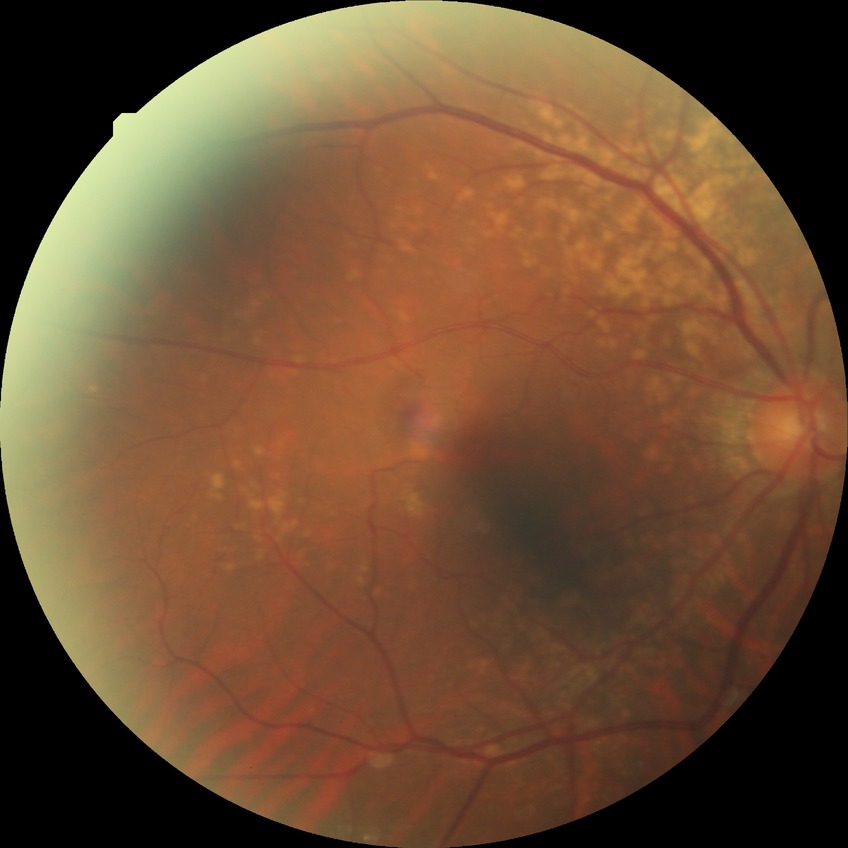

diabetic retinopathy (DR)@no diabetic retinopathy (NDR).